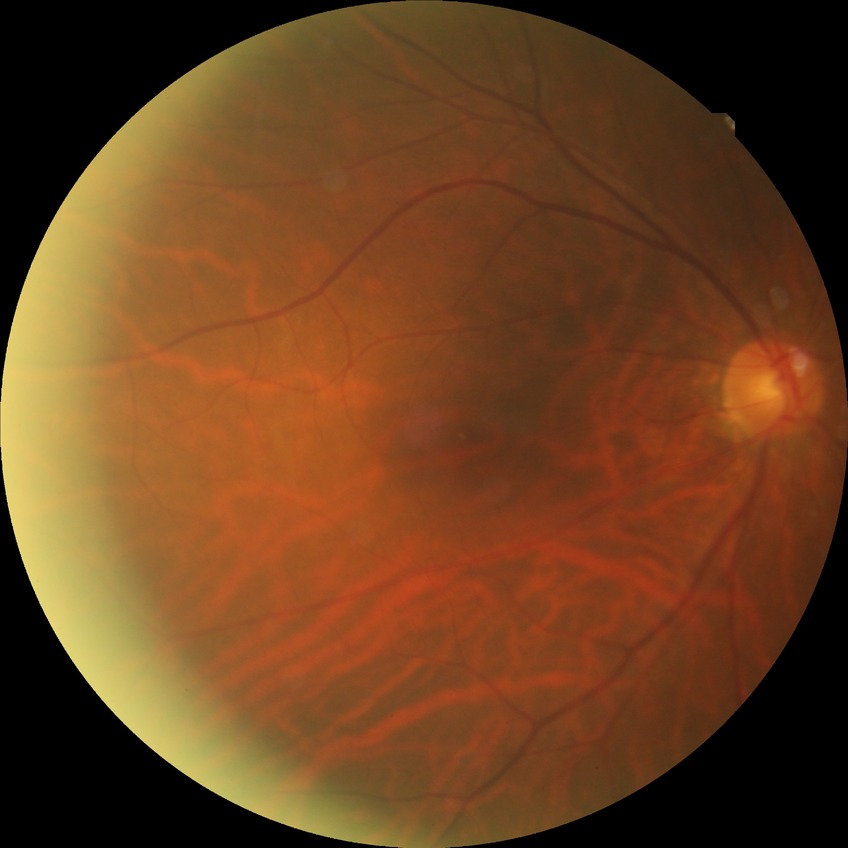

Diabetic retinopathy severity is no diabetic retinopathy.